Nonmydriatic fundus photograph, image size 848x848, camera: NIDEK AFC-230: 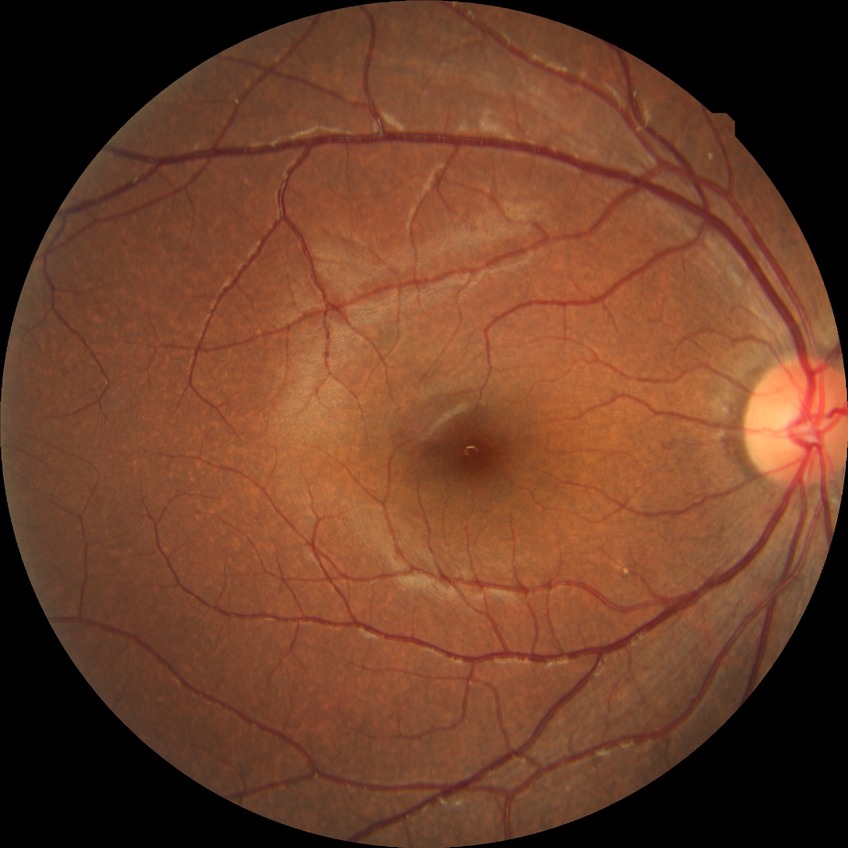 diabetic retinopathy (DR) = no diabetic retinopathy (NDR).